Acquired on the Clarity RetCam 3 · infant wide-field fundus photograph: 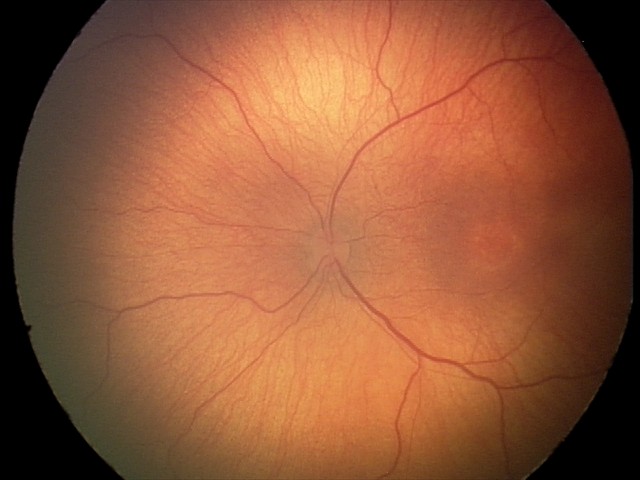 Assessment = retinopathy of prematurity (ROP) stage 2.